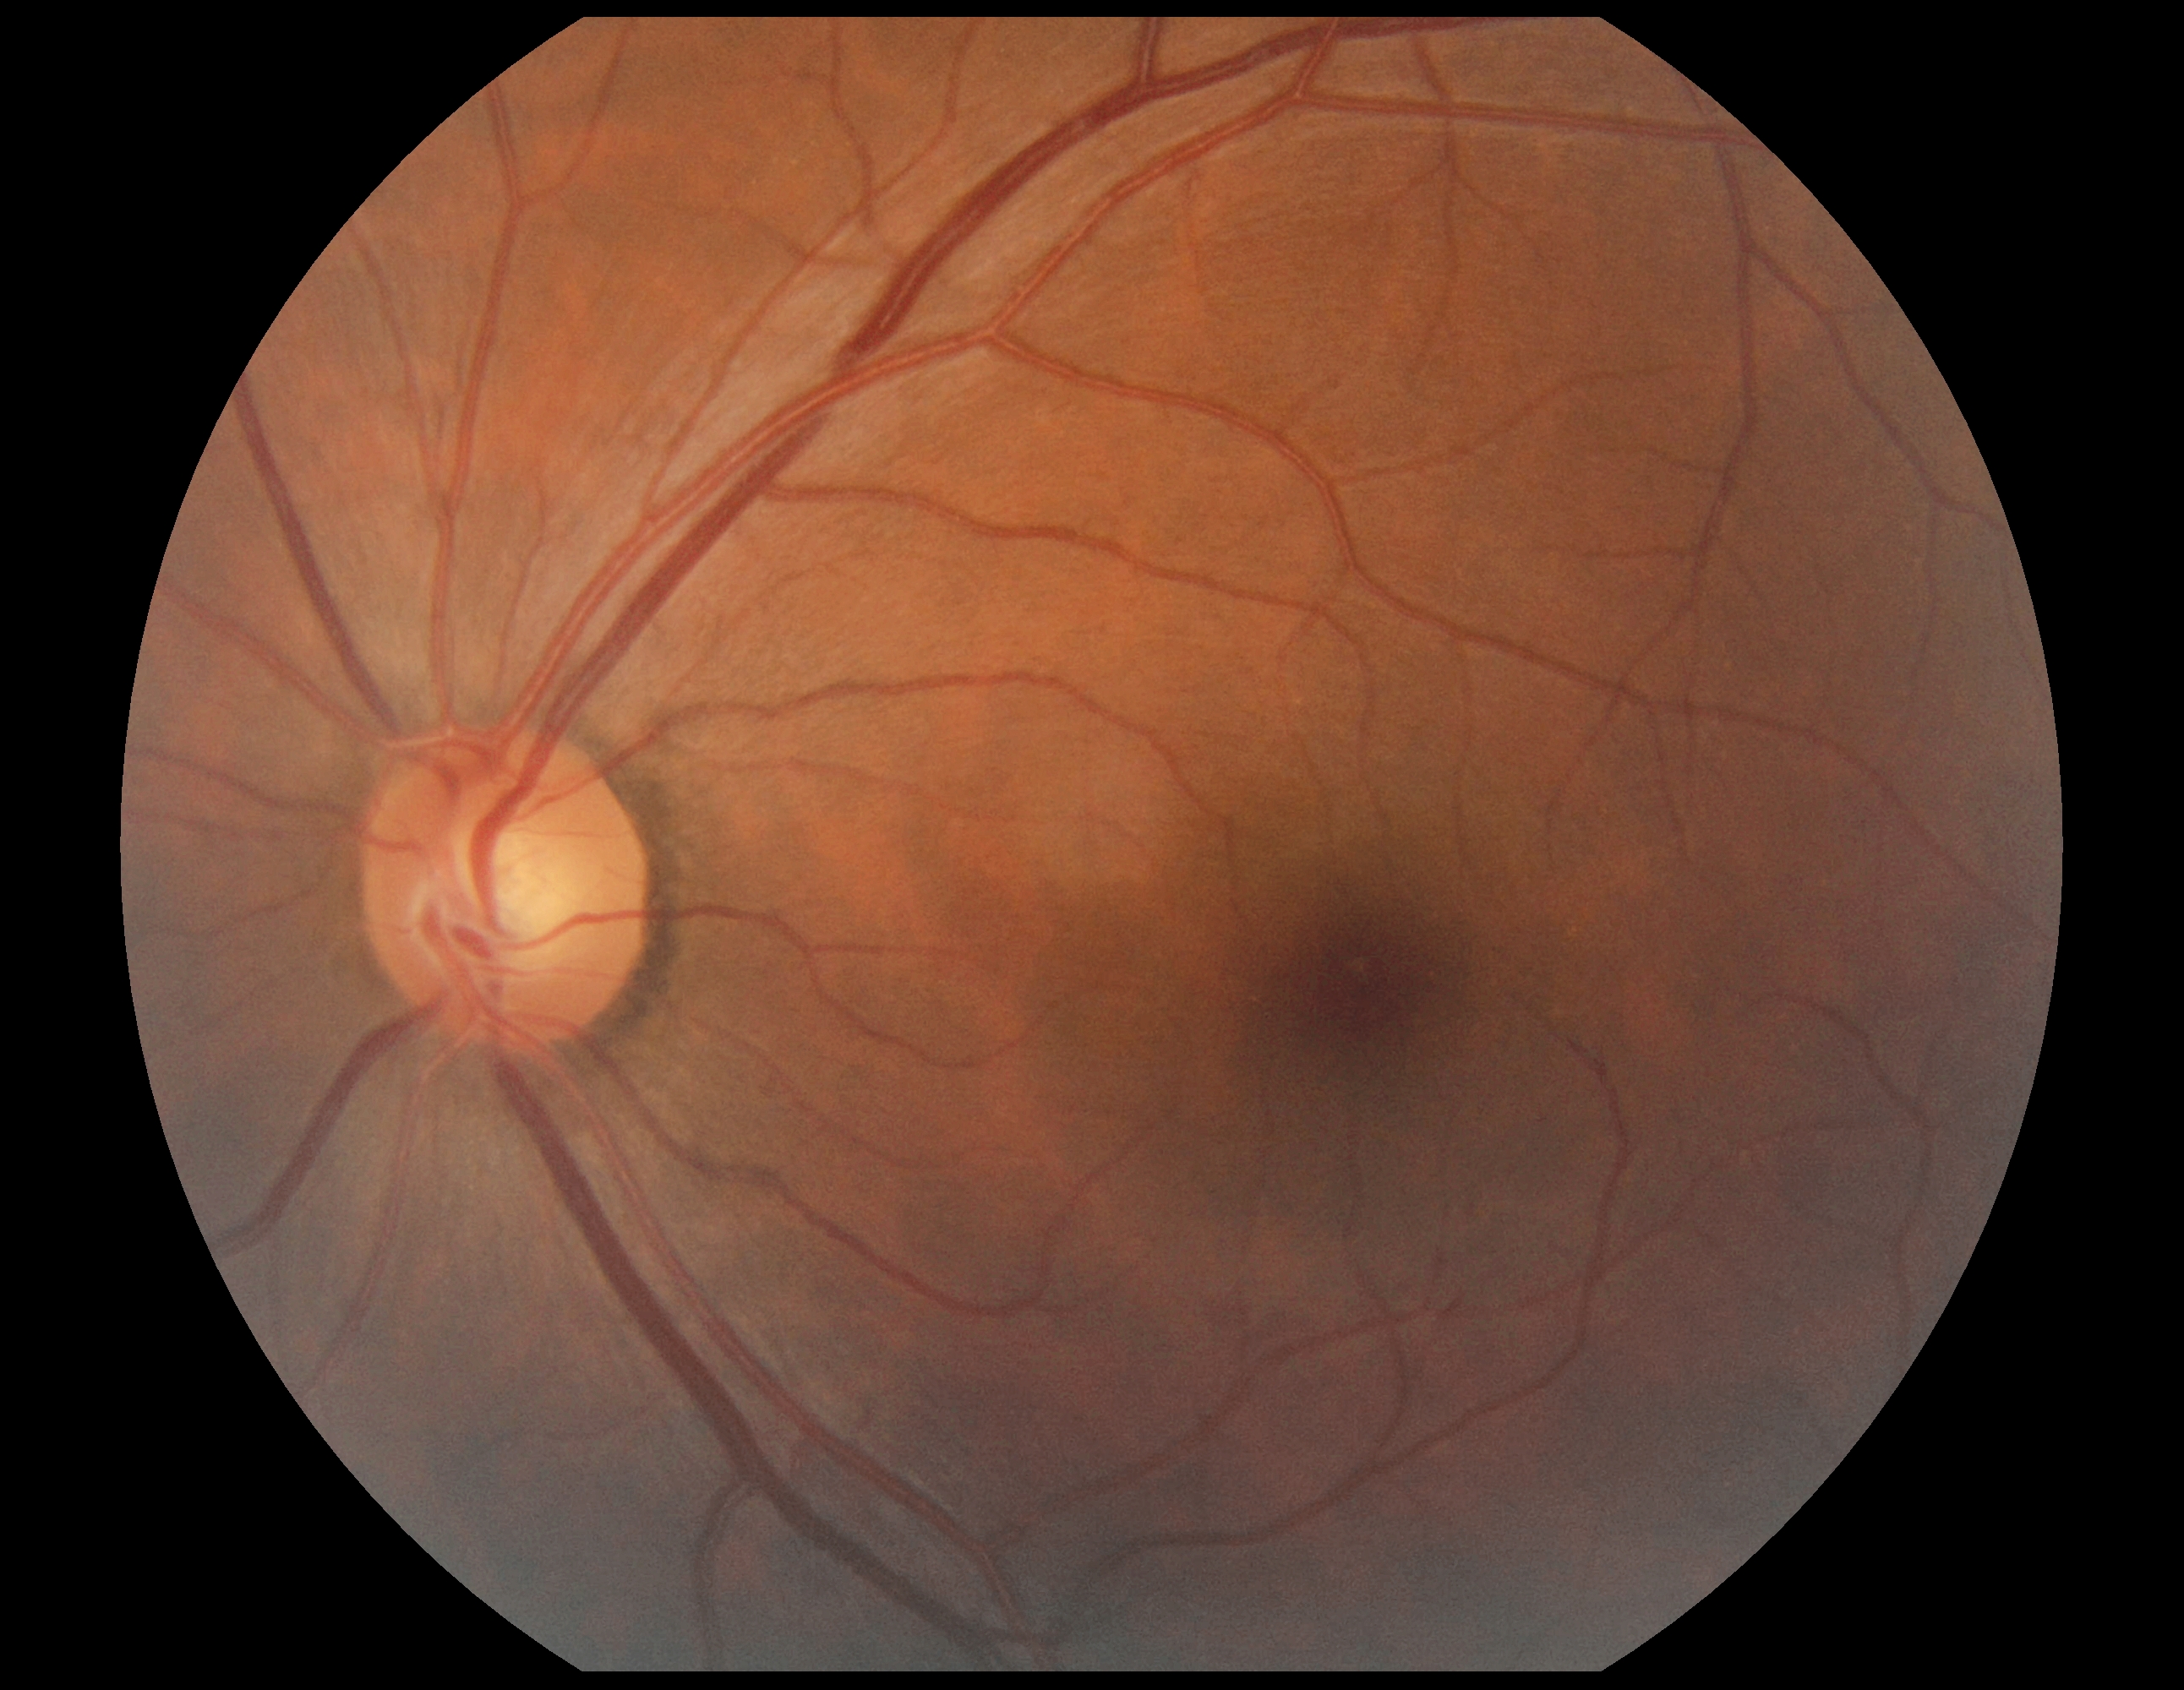
Findings:
• DR stage: no apparent retinopathy (grade 0)